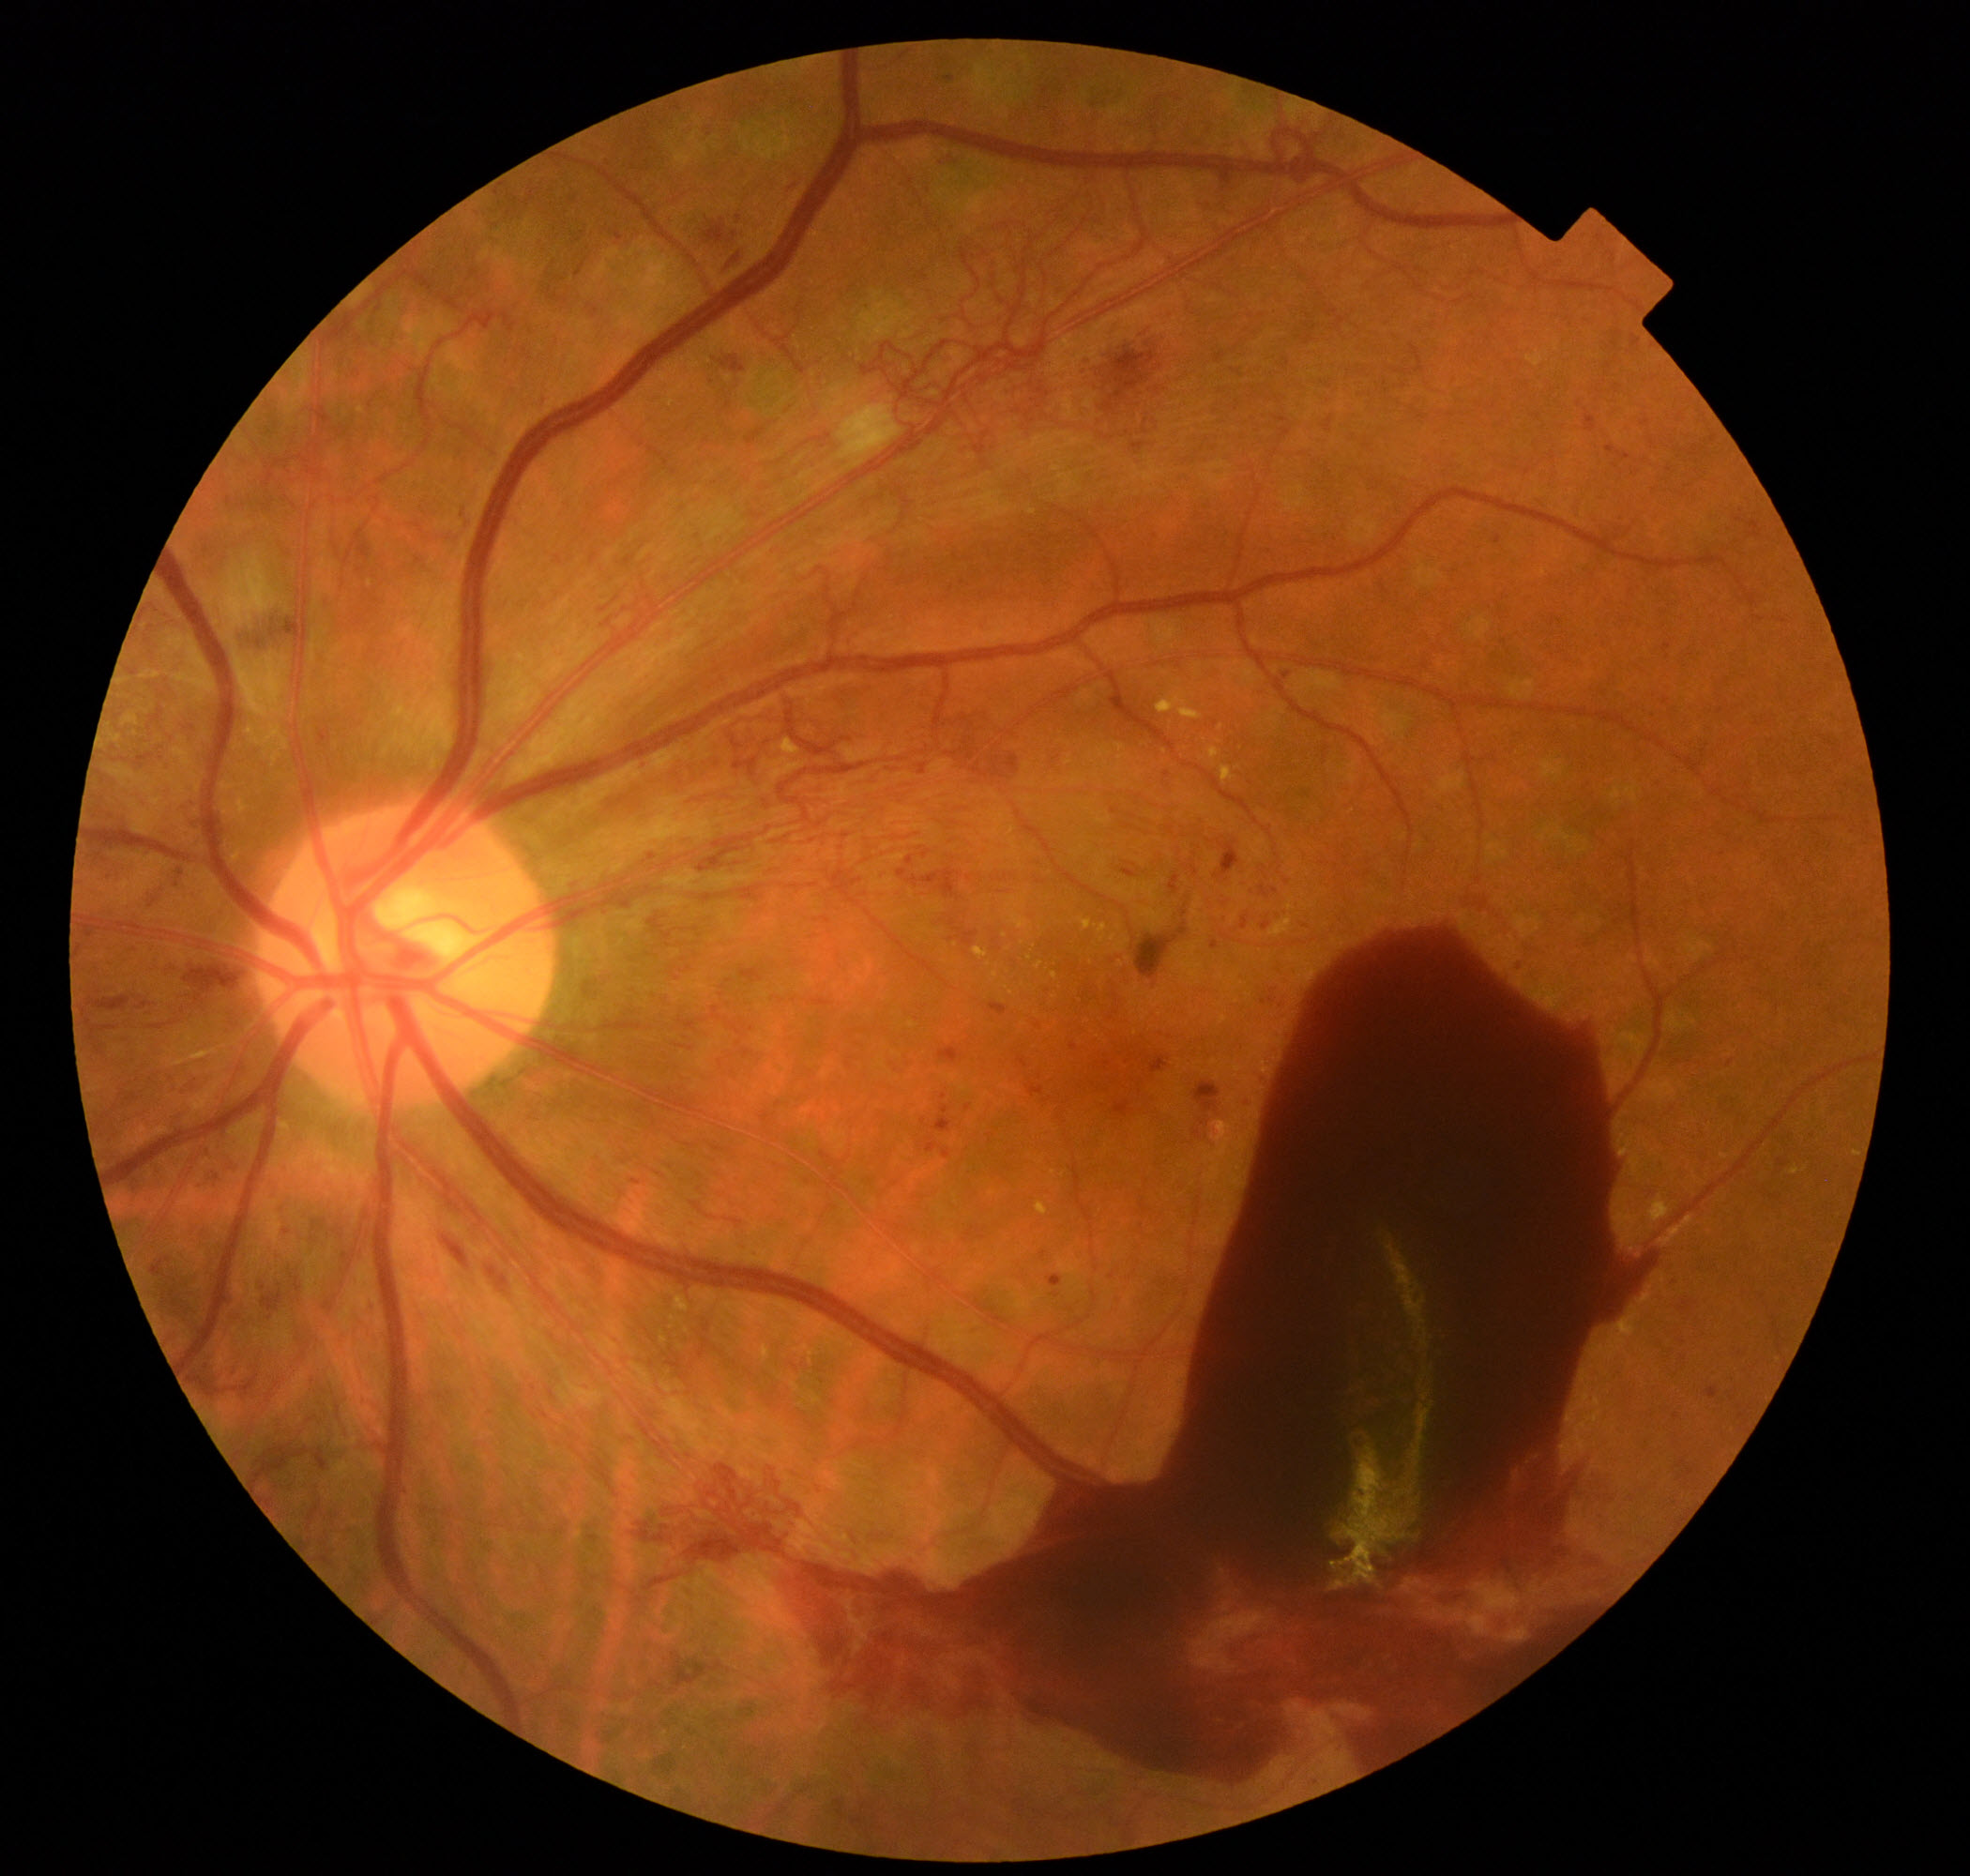
Findings: severe non-proliferative or proliferative diabetic retinopathy.